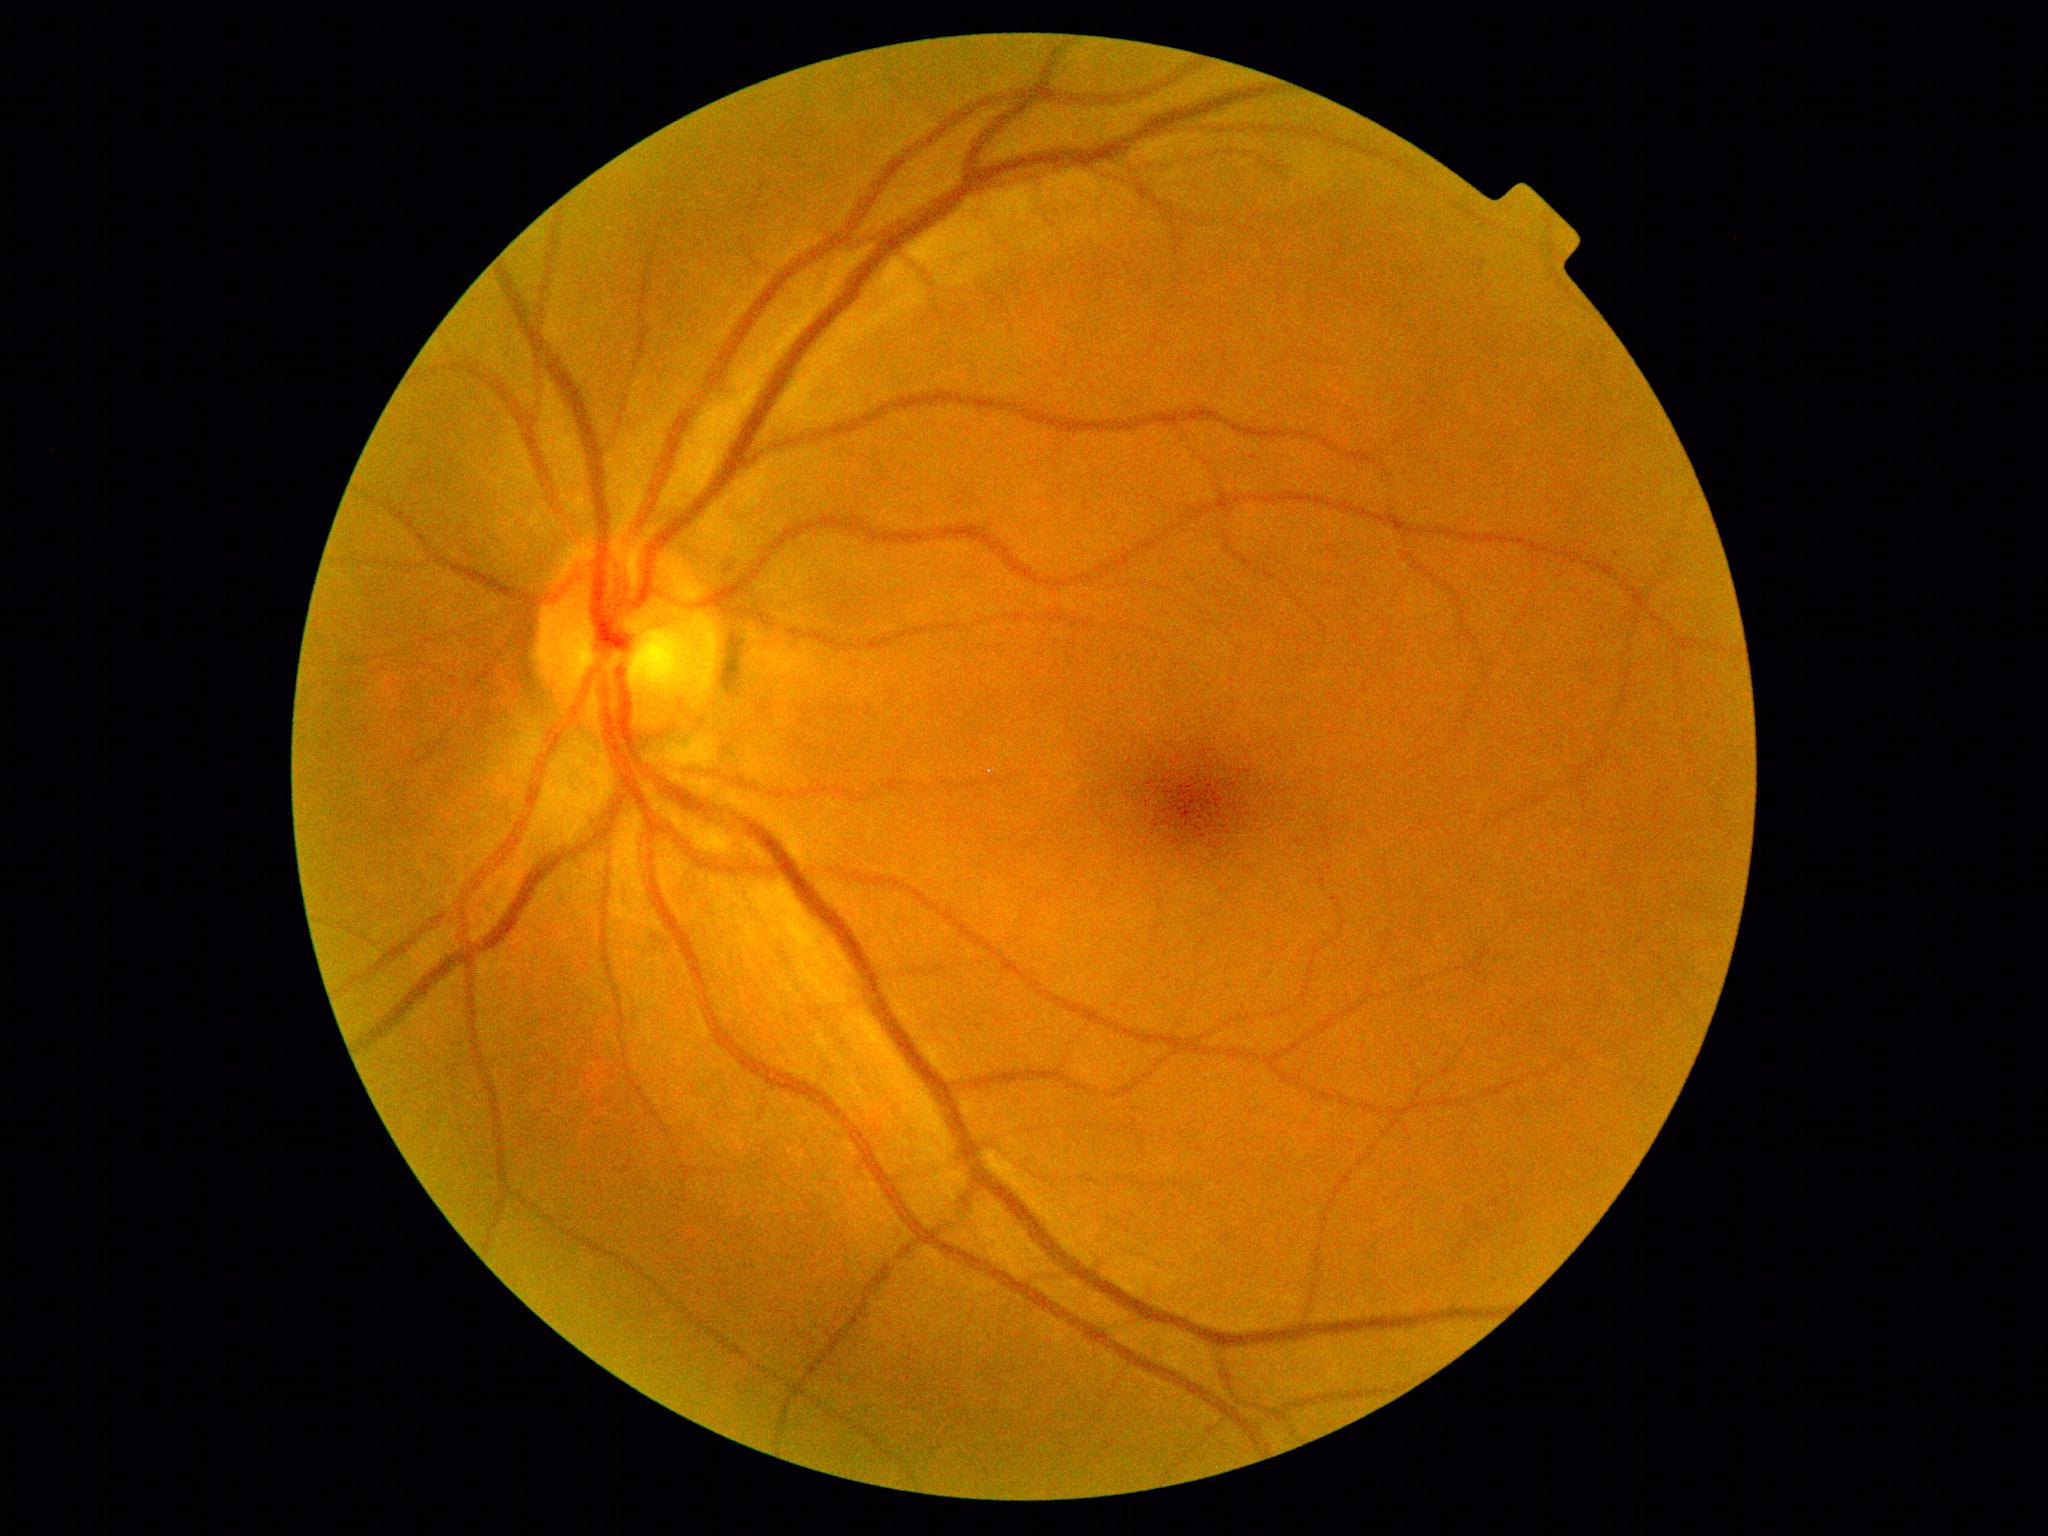
No diabetic retinal disease findings.
Retinopathy is 0.